Phoenix ICON wide-field infant fundus image:
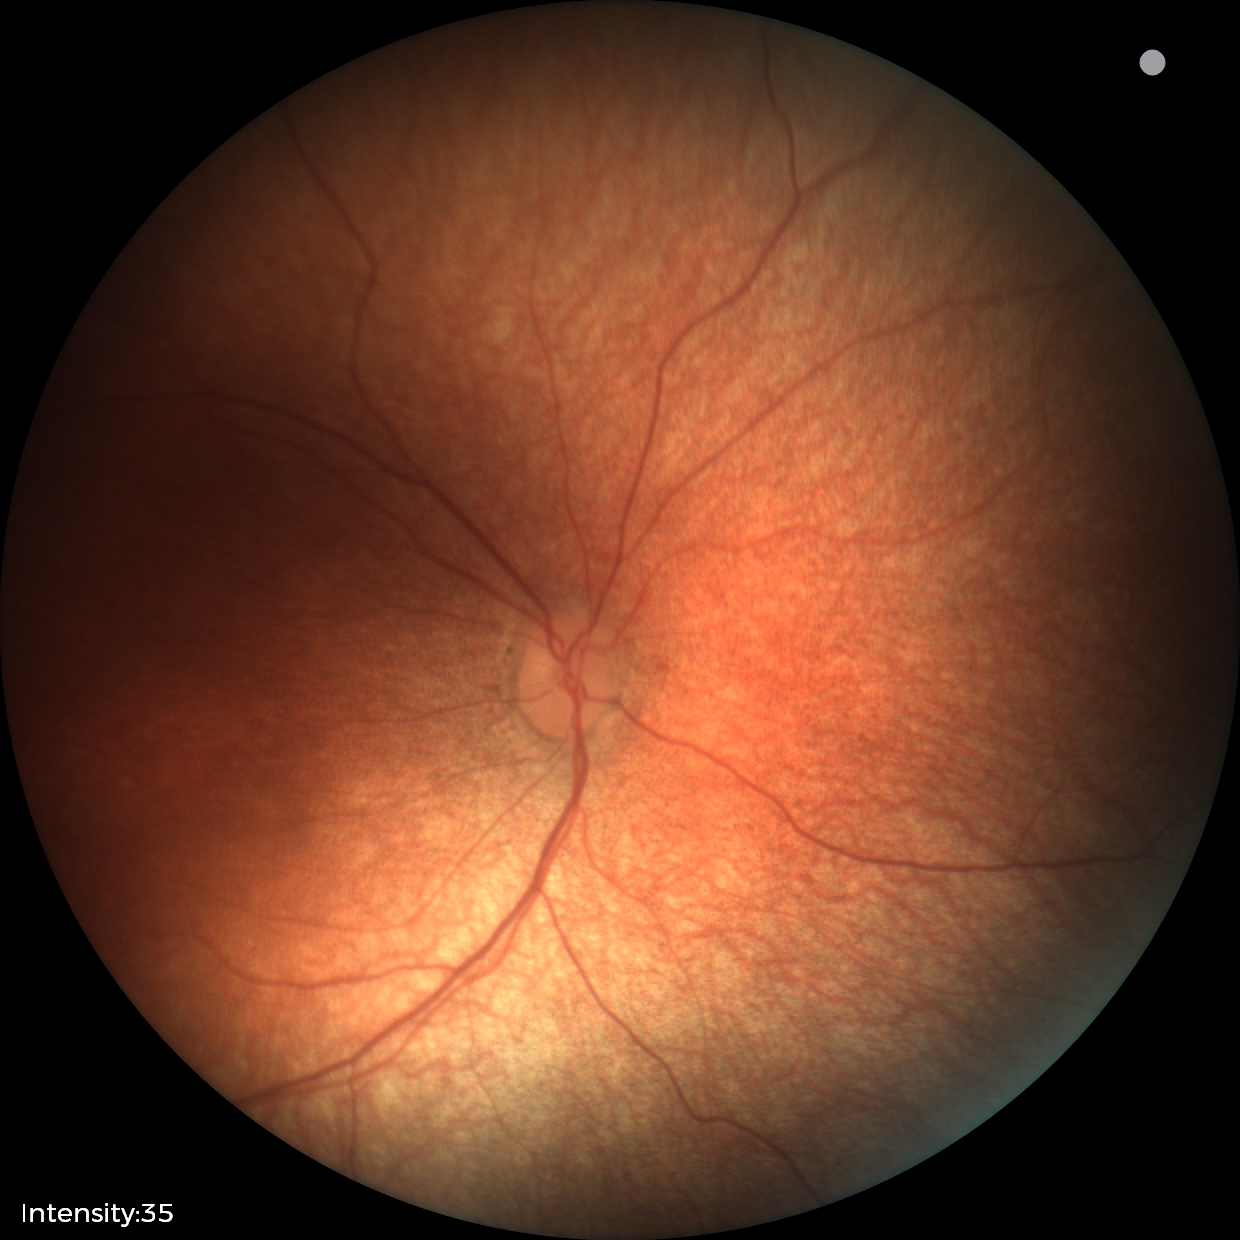

No retinal pathology identified on screening.